Wide-field fundus photograph of an infant. Captured with the Phoenix ICON (100° field of view). 1240x1240px.
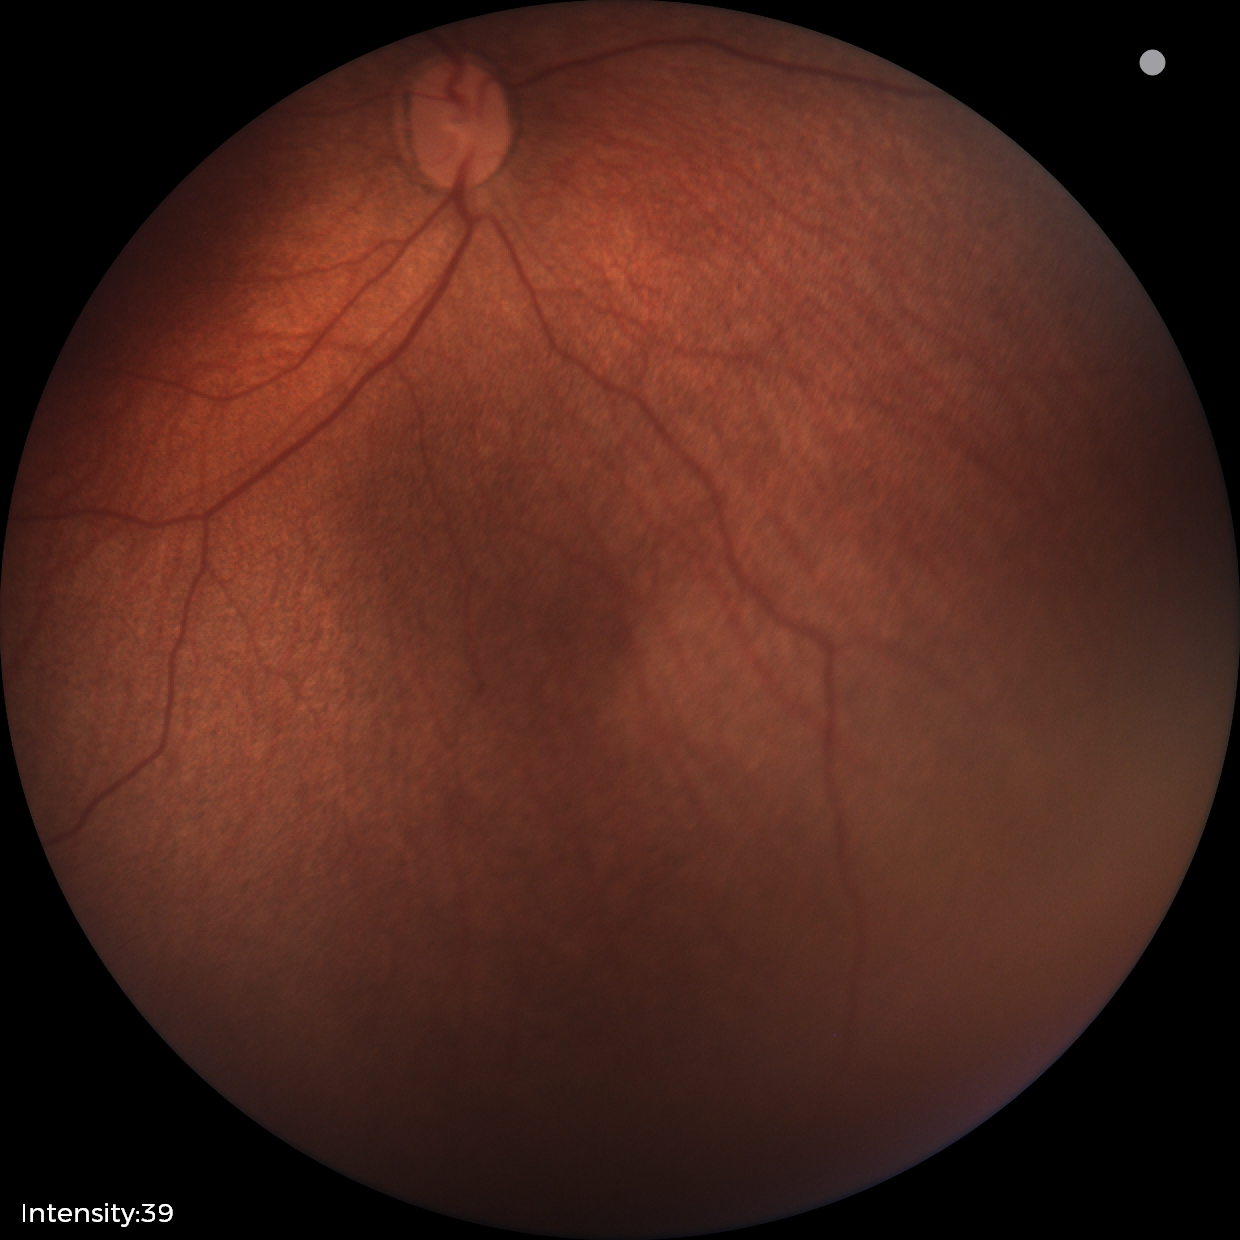

Assessment: status post ROP.